NIDEK AFC-230 fundus camera
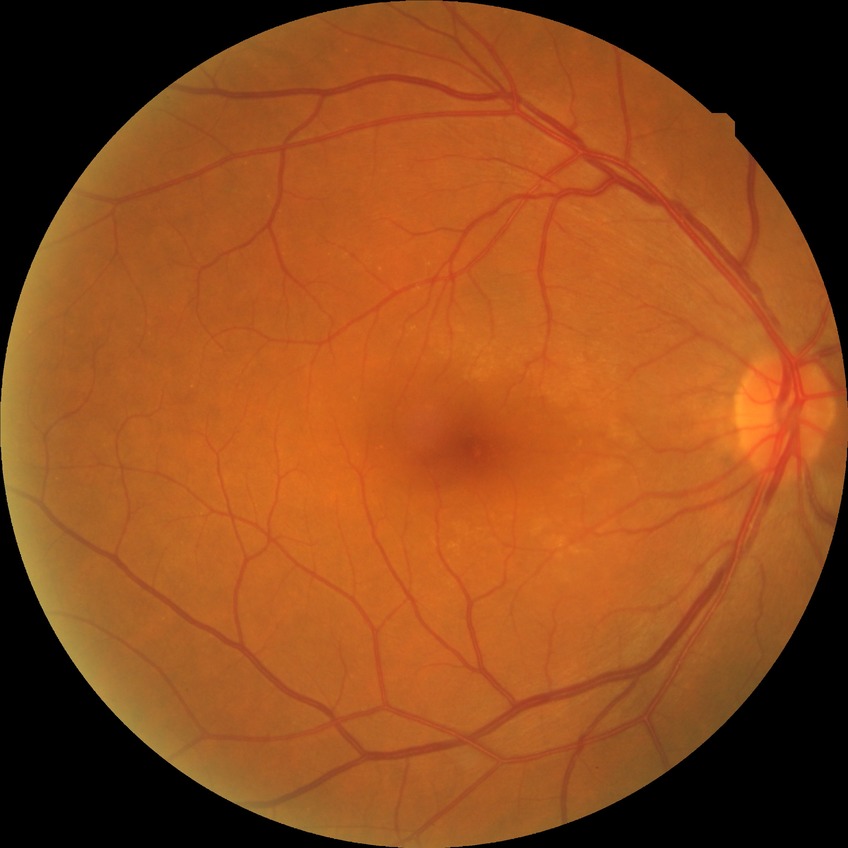 Diabetic retinopathy (DR): no diabetic retinopathy (NDR).